DR severity per modified Davis staging; nonmydriatic; NIDEK AFC-230 fundus camera.
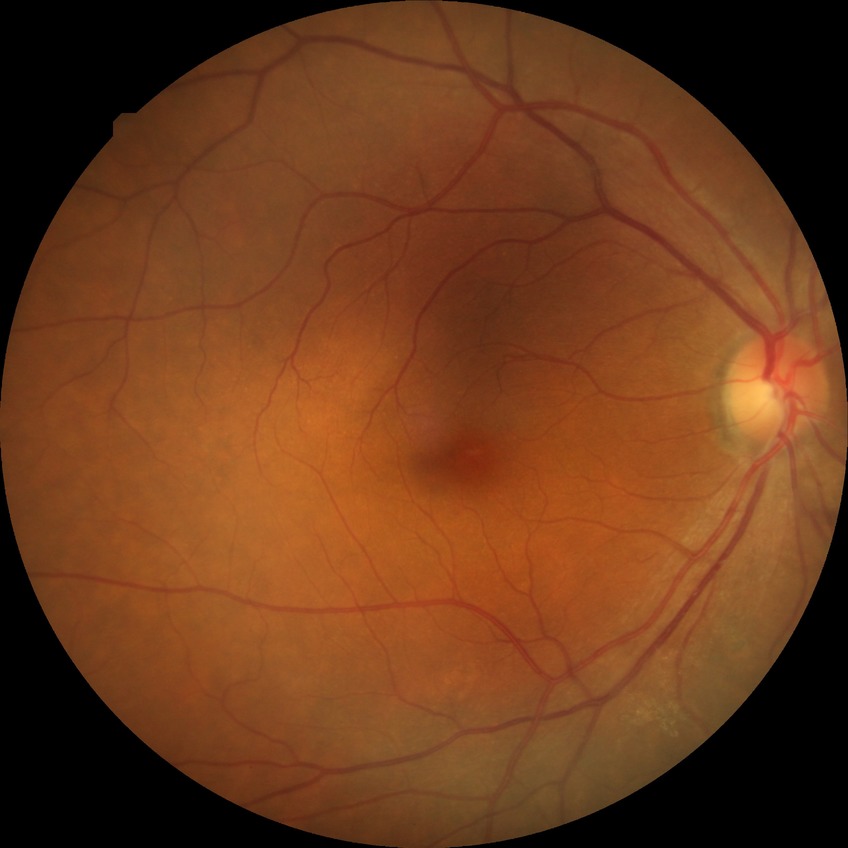

Modified Davis grade is NDR.